45° field of view · 848 x 848 pixels · nonmydriatic: 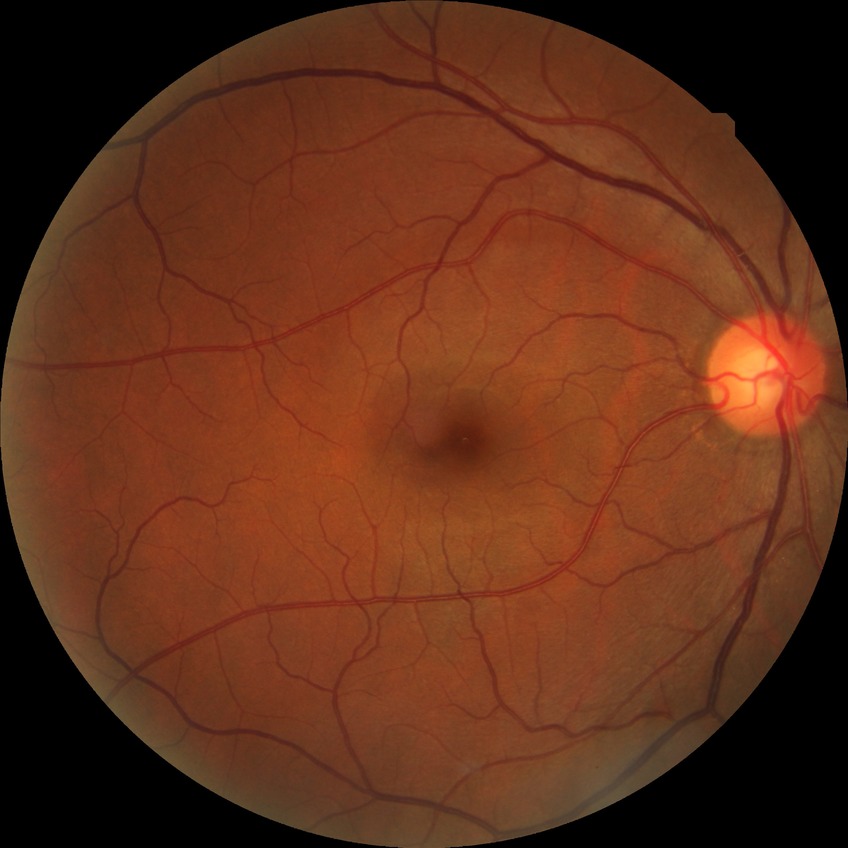
Diabetic retinopathy (DR): NDR (no diabetic retinopathy).